Acquired on the Natus RetCam Envision. 1440 x 1080 pixels. Pediatric retinal photograph (wide-field): 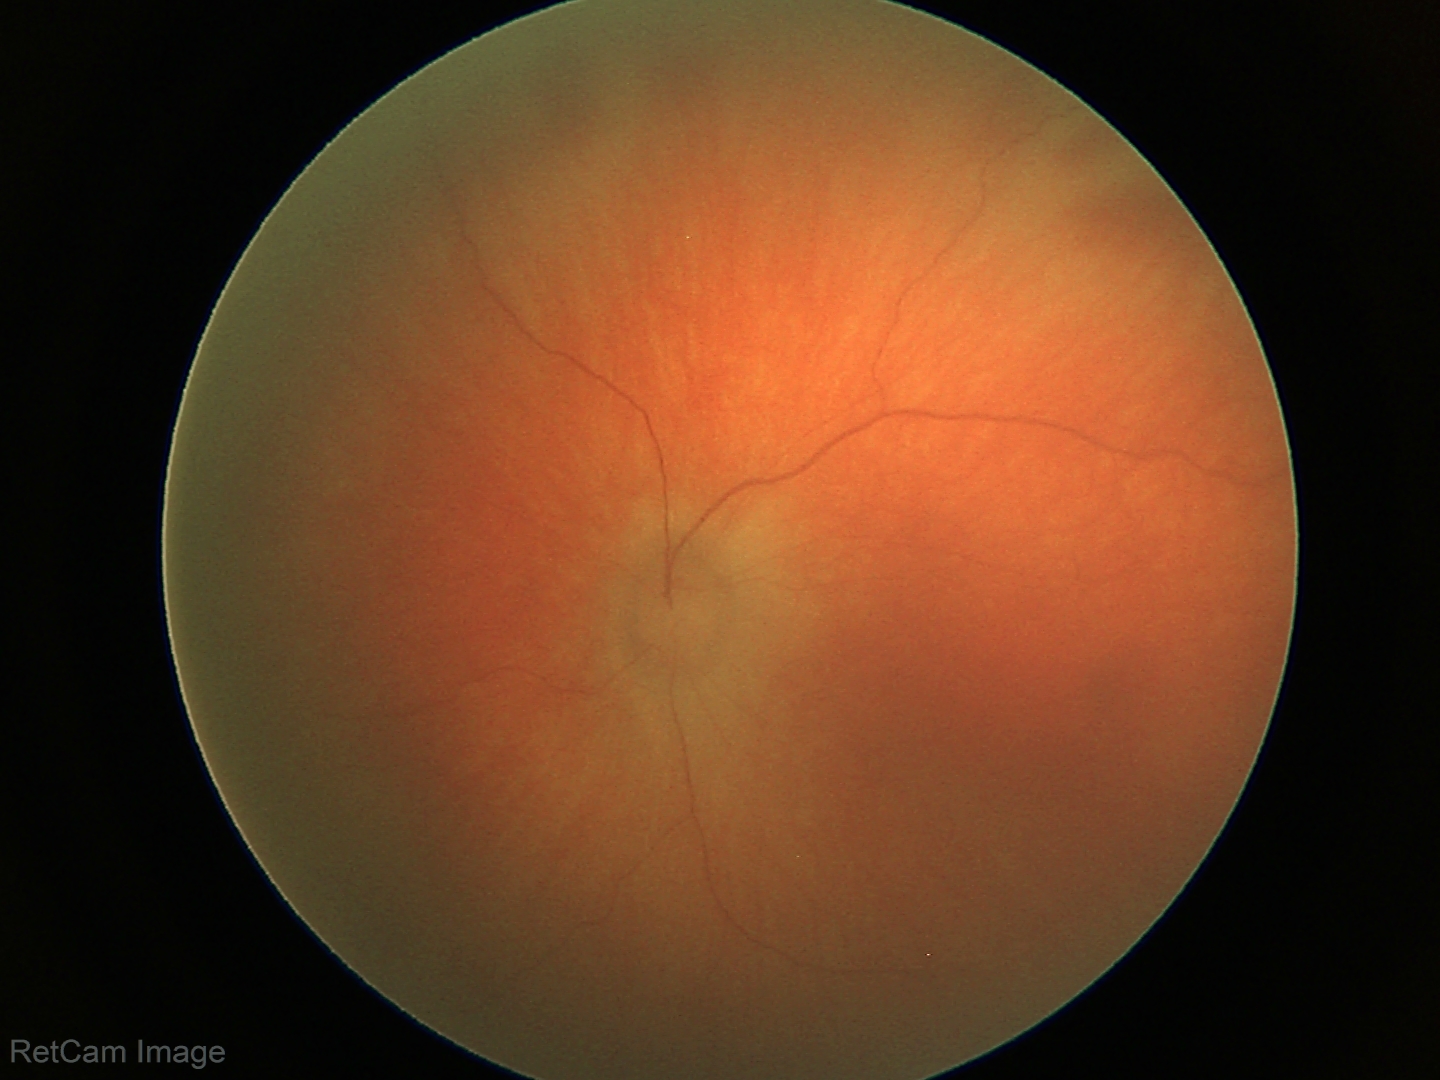

Screening examination consistent with retinal hemorrhages.